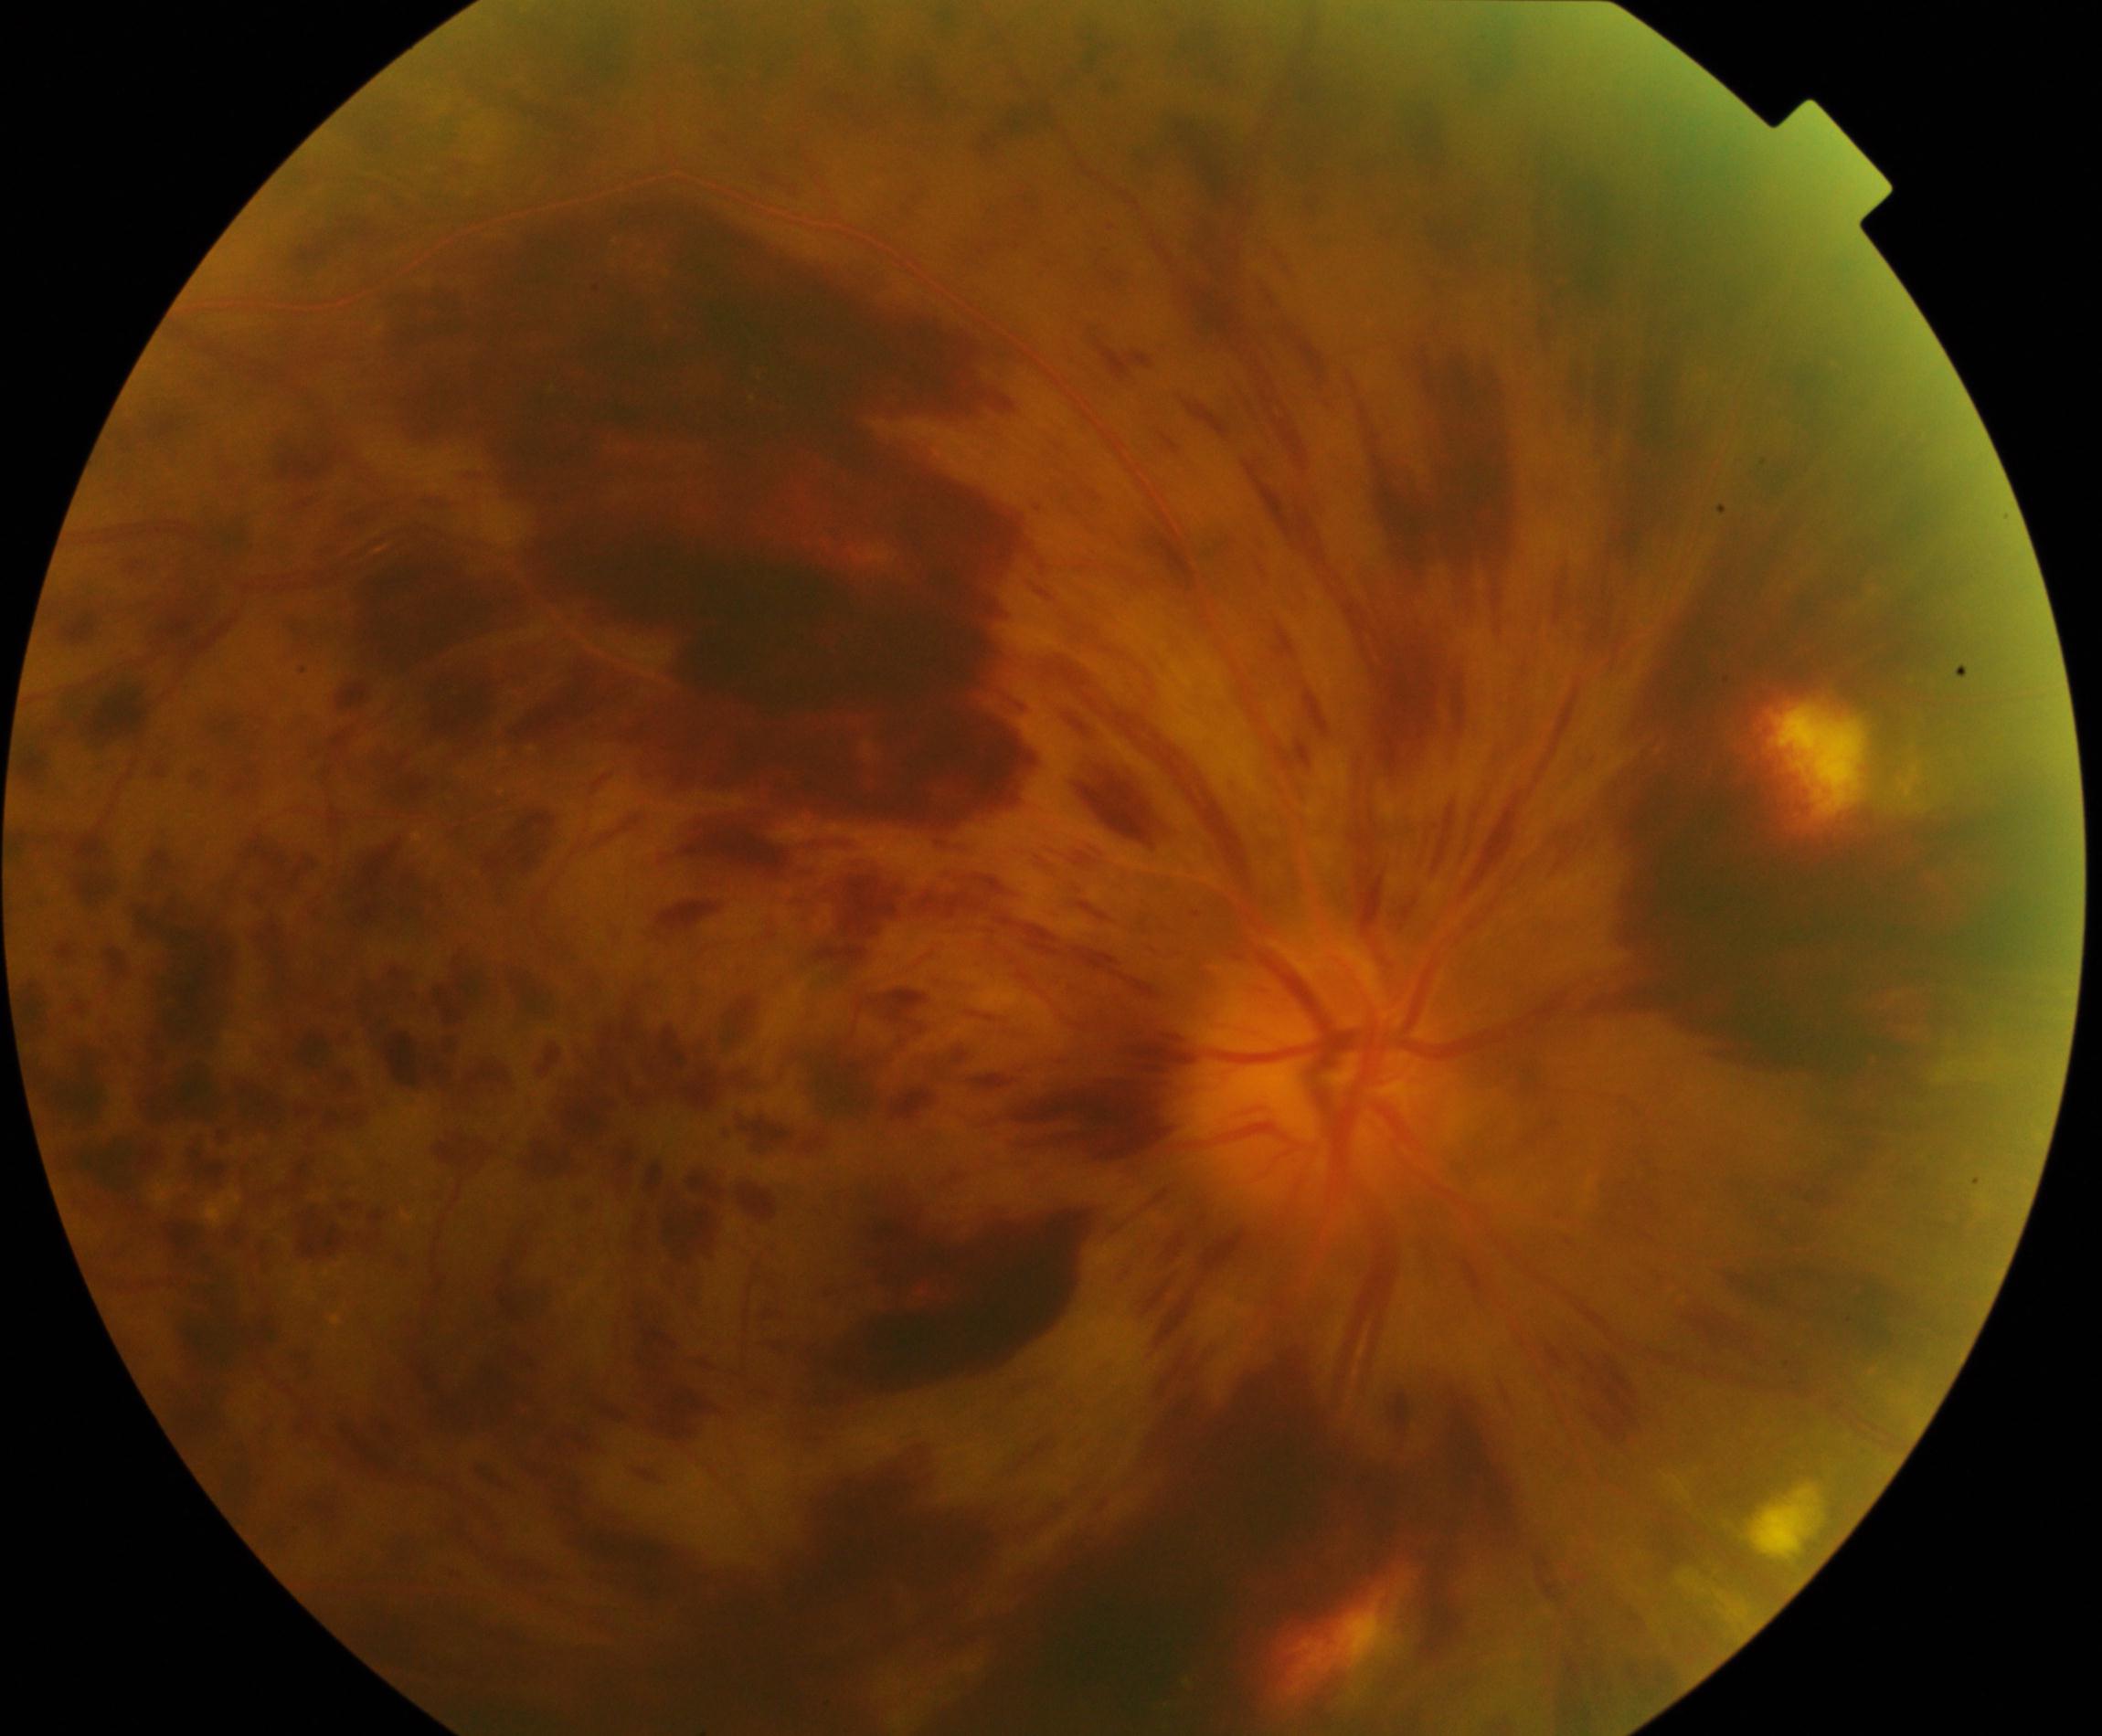
Fundus appearance consistent with CRVO (central retinal vein occlusion). Typically showing tortuosity and dilatation of all branches of veins, with dot, blot, and flame hemorrhages, sometimes with cotton-wool spots or hard exudates.